Topcon TRC-50DX
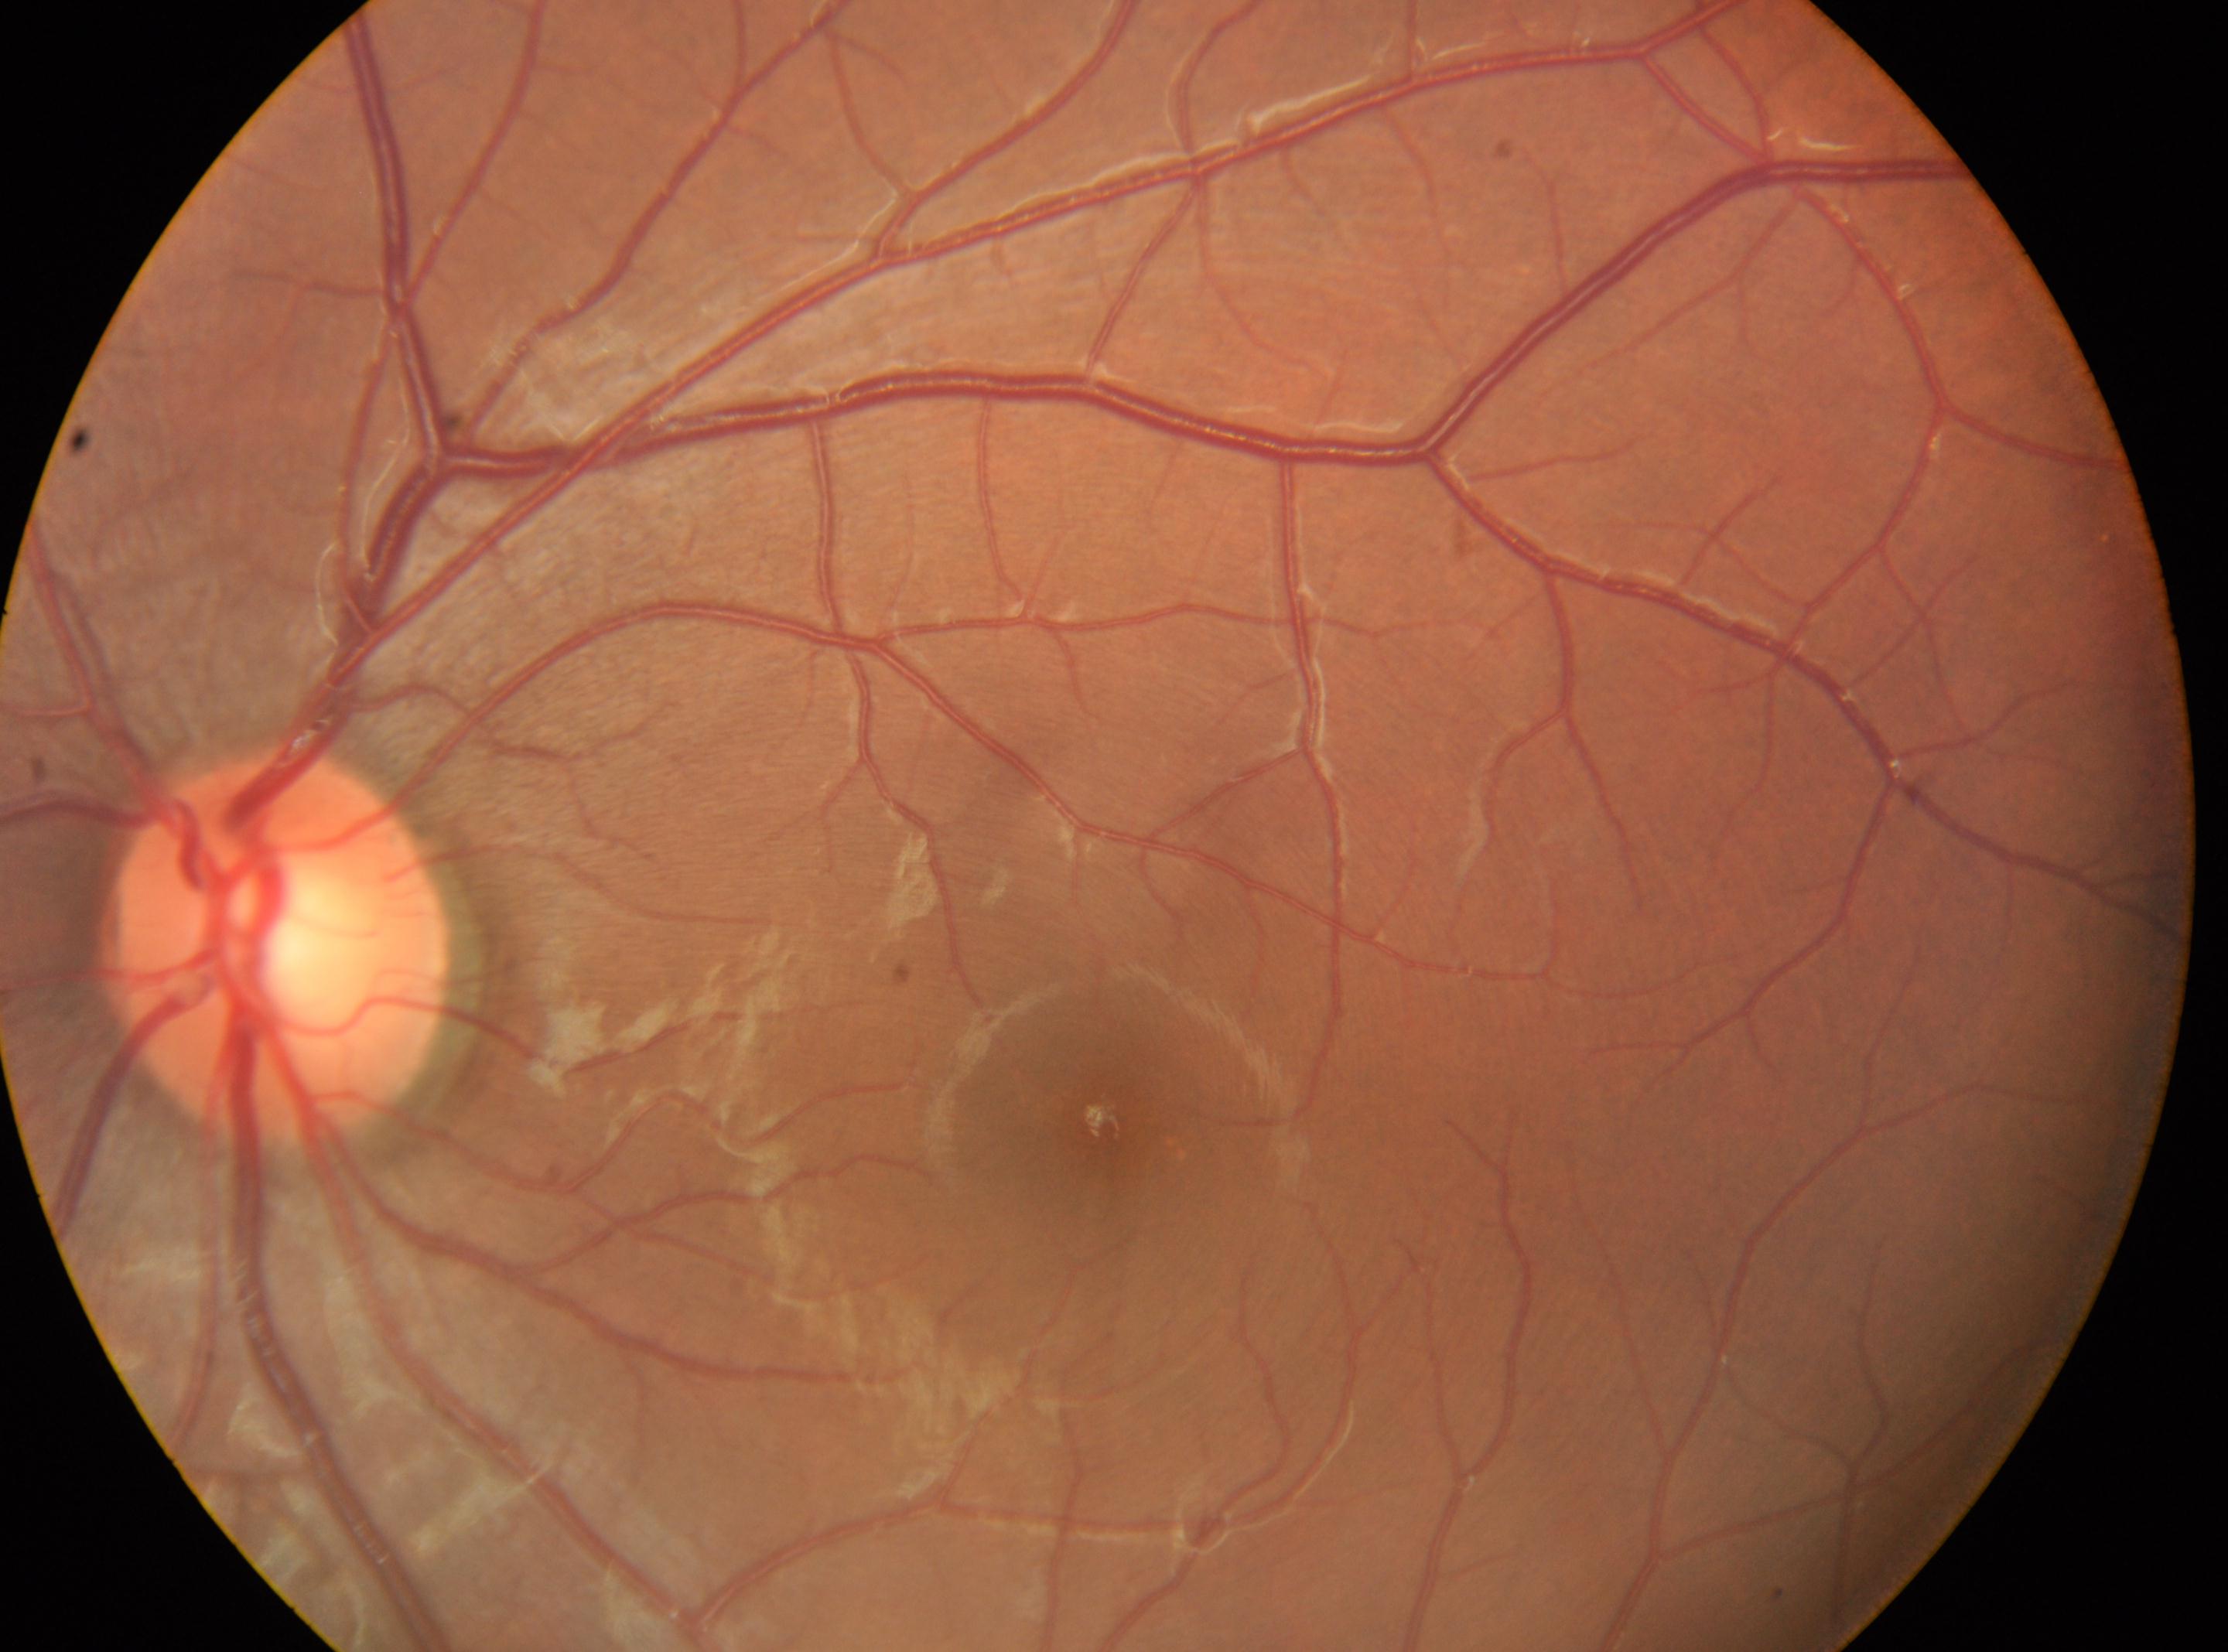

Diabetic retinopathy severity: grade 0.
Eye: the left eye.
Disc center located at x=277, y=950.
Fovea center located at x=1105, y=1128.